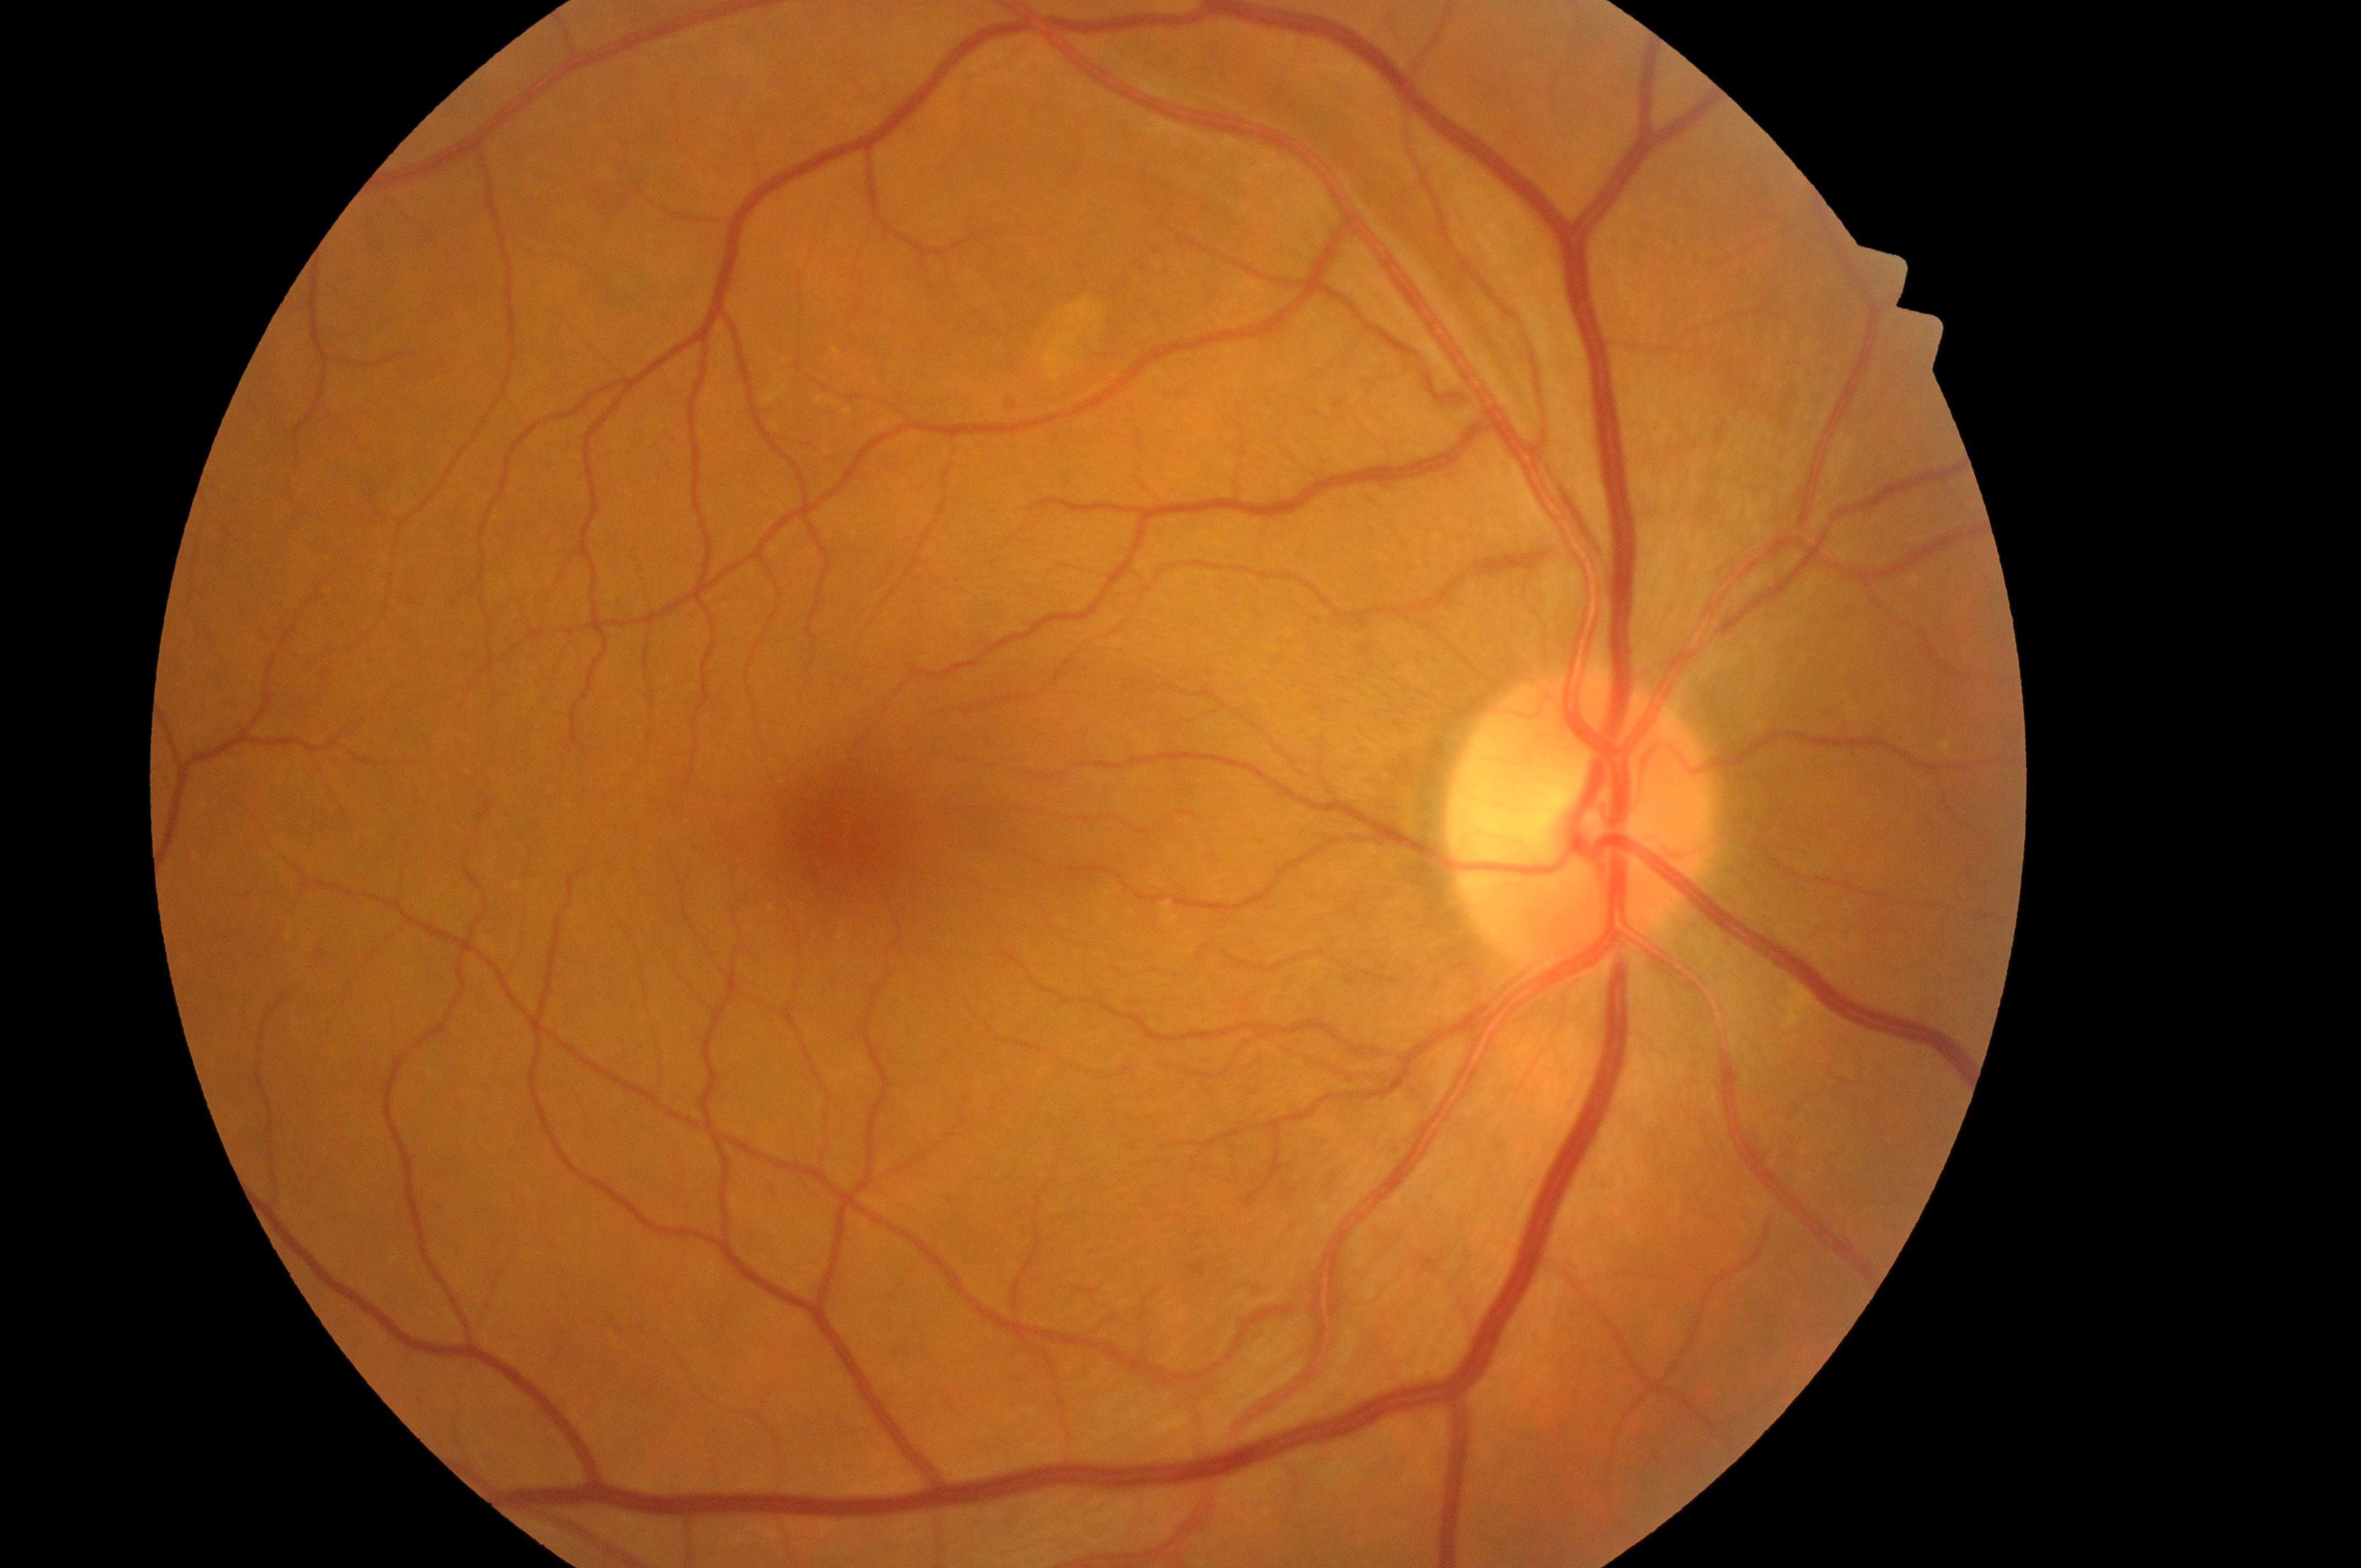

No diabetic retinal disease findings.
Eye: right.
DR grade is 0.
Optic disk: 1574, 826.
Fovea center: 858, 831.
DME is 0/2.